Infant wide-field fundus photograph; 1440x1080; acquired on the Natus RetCam Envision
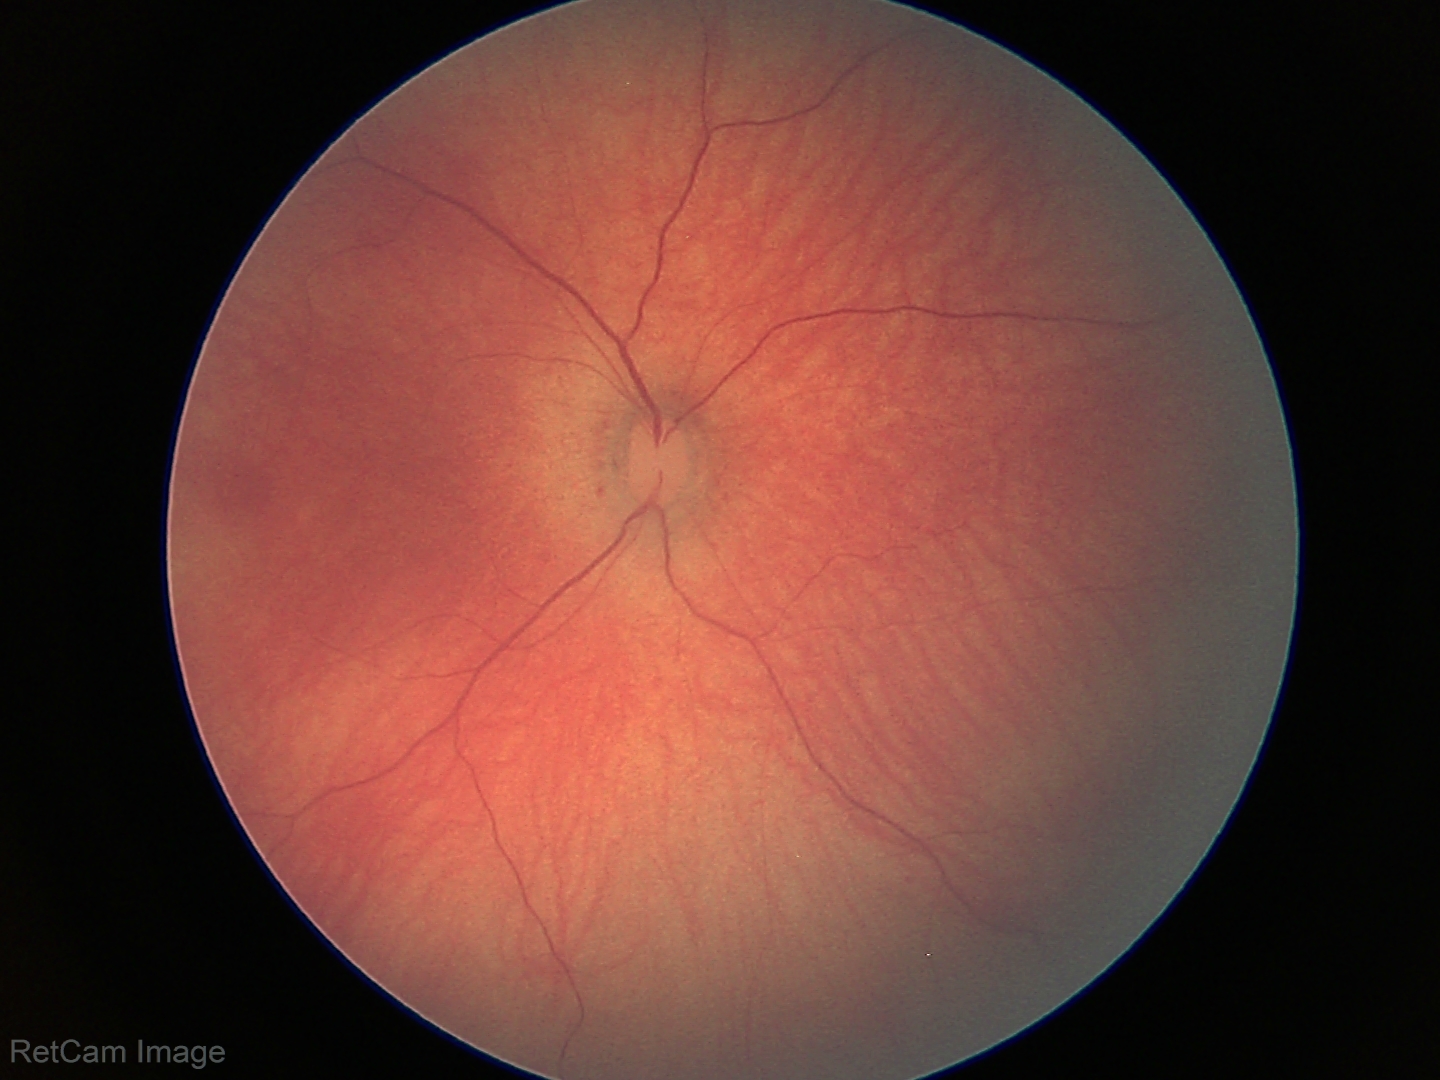

Screening examination with no abnormal retinal findings.